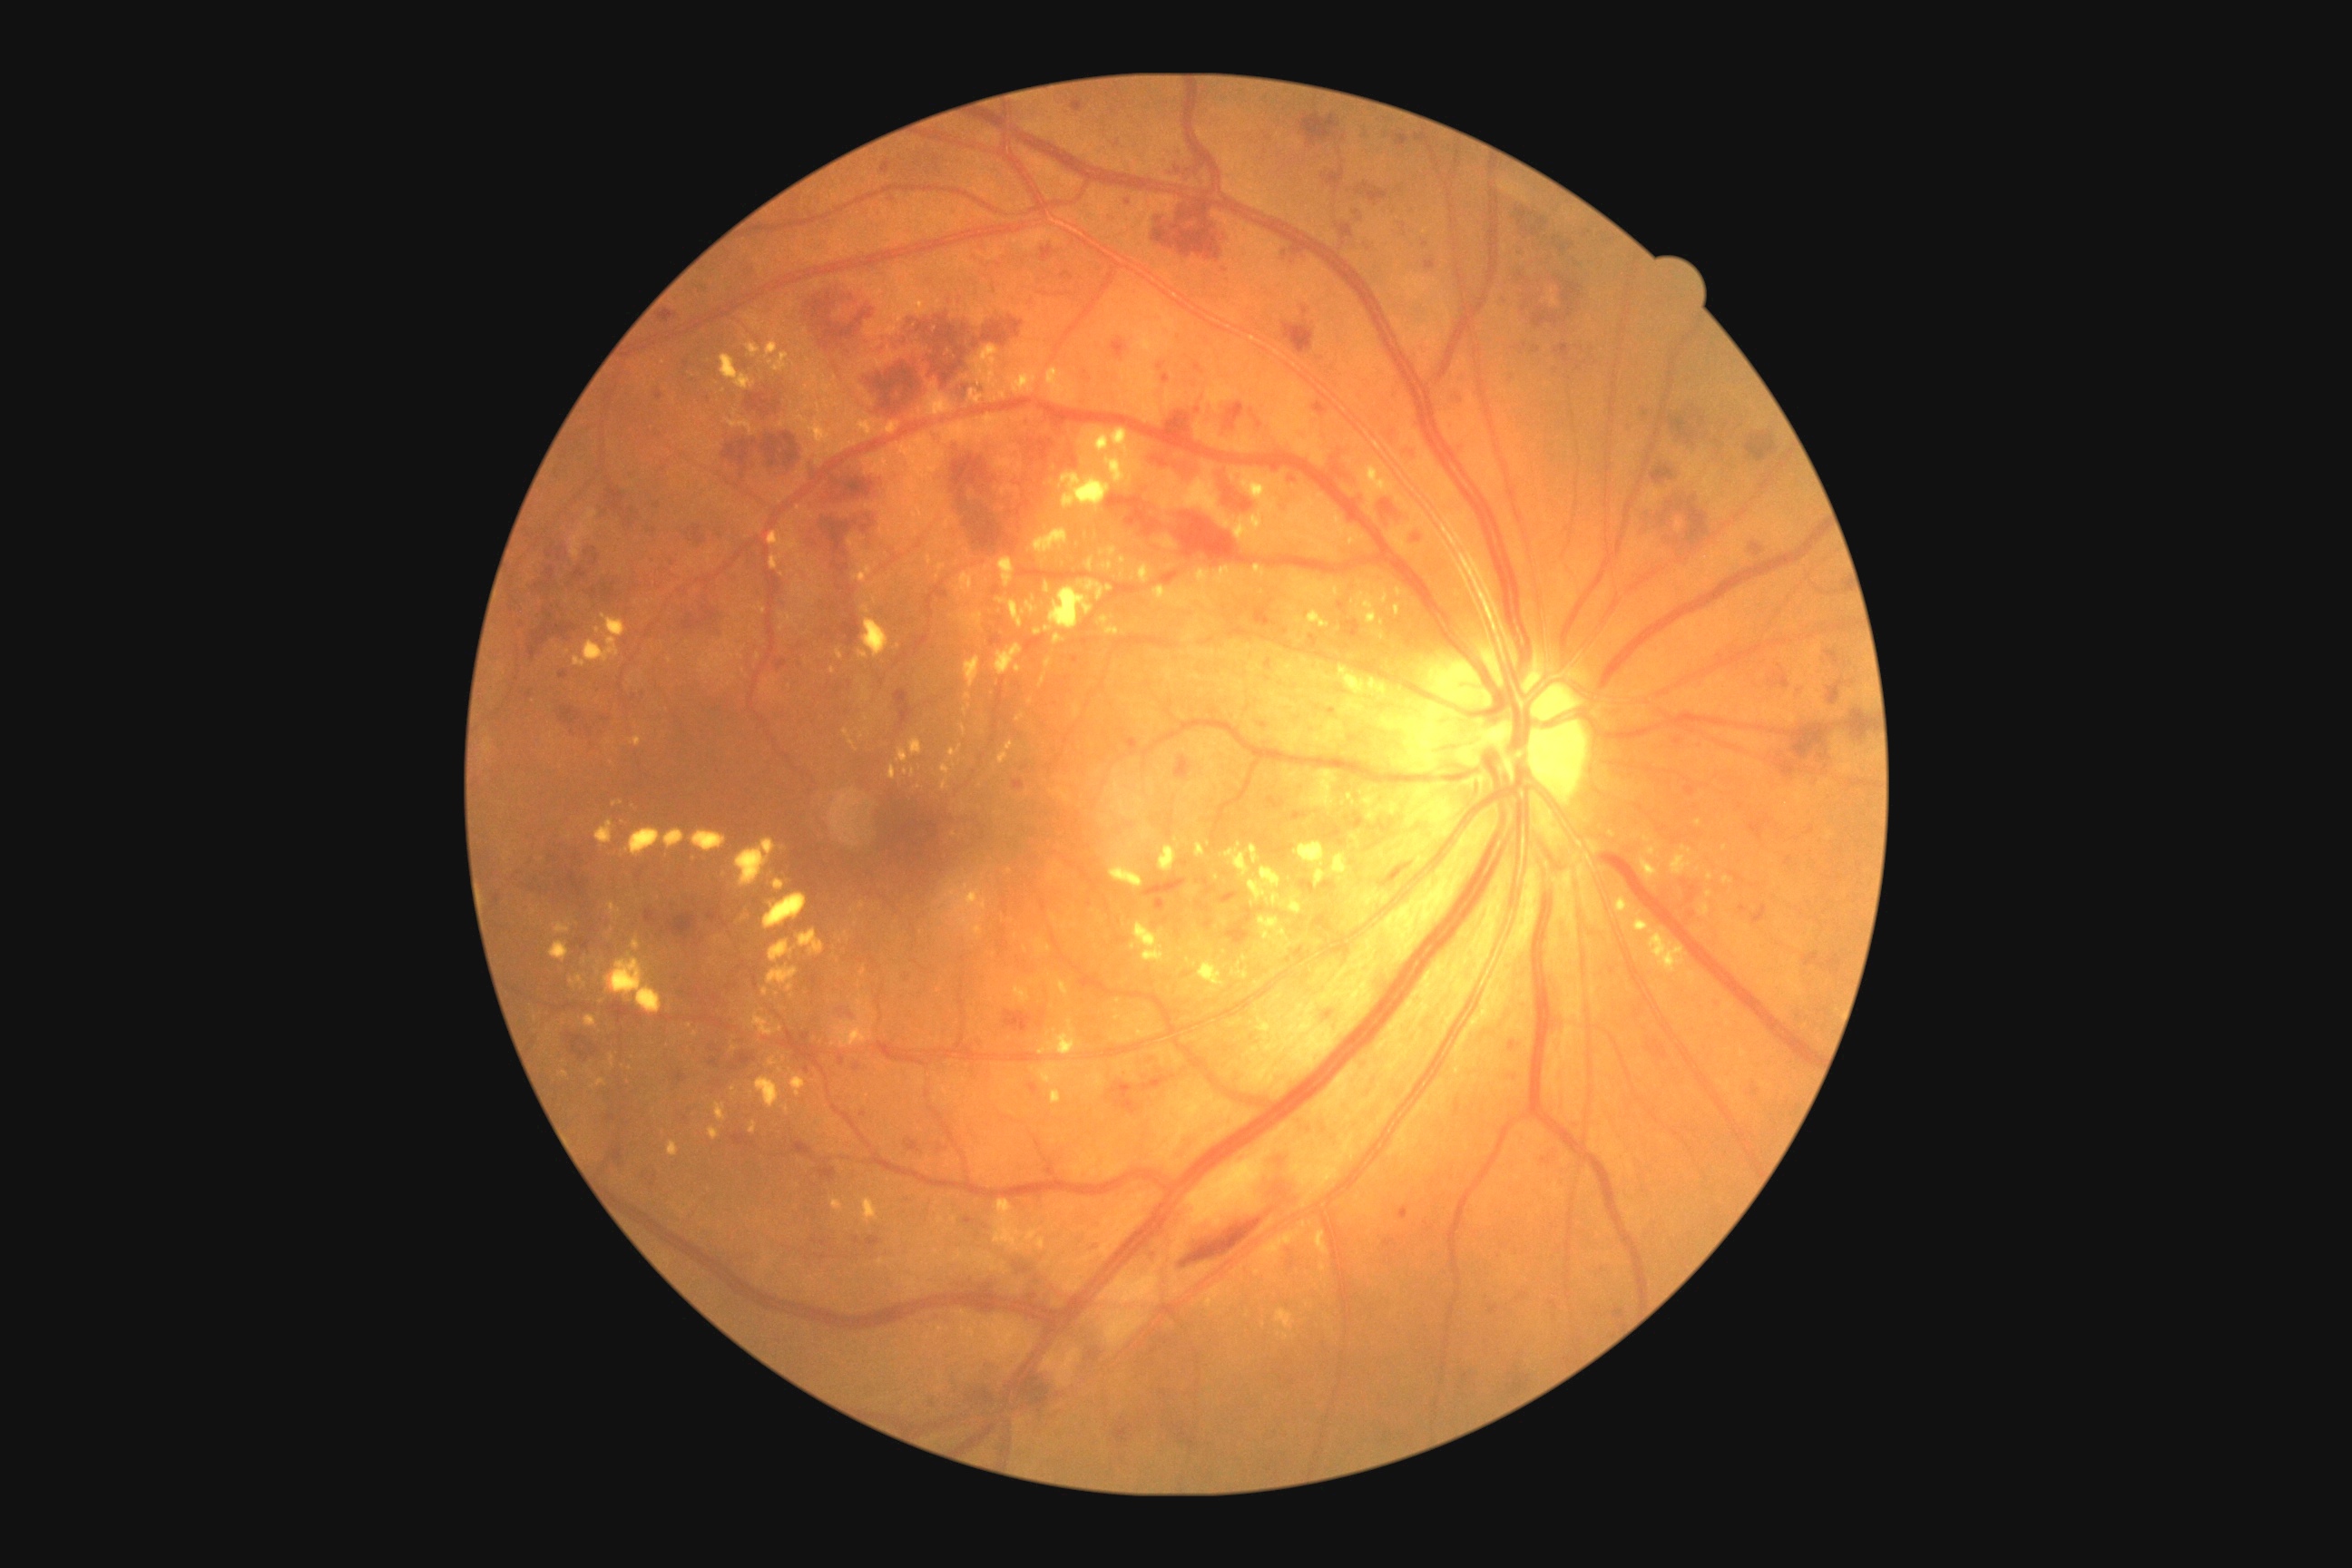 Retinopathy grade is 3
Selected lesions:
hard exudates (more not shown): 747:344:761:357; 999:391:1008:400; 1079:580:1113:602; 1044:587:1093:632; 845:932:850:941; 783:1106:790:1115; 948:745:963:763; 963:705:972:716; 897:749:908:763; 961:612:985:627; 1152:712:1157:720; 1159:847:1177:872; 1034:529:1068:554; 1184:888:1199:897; 769:525:801:571
Small hard exudates approximately at x=867, y=718; x=777, y=995; x=875, y=582; x=937, y=578